Camera: NIDEK AFC-230 — 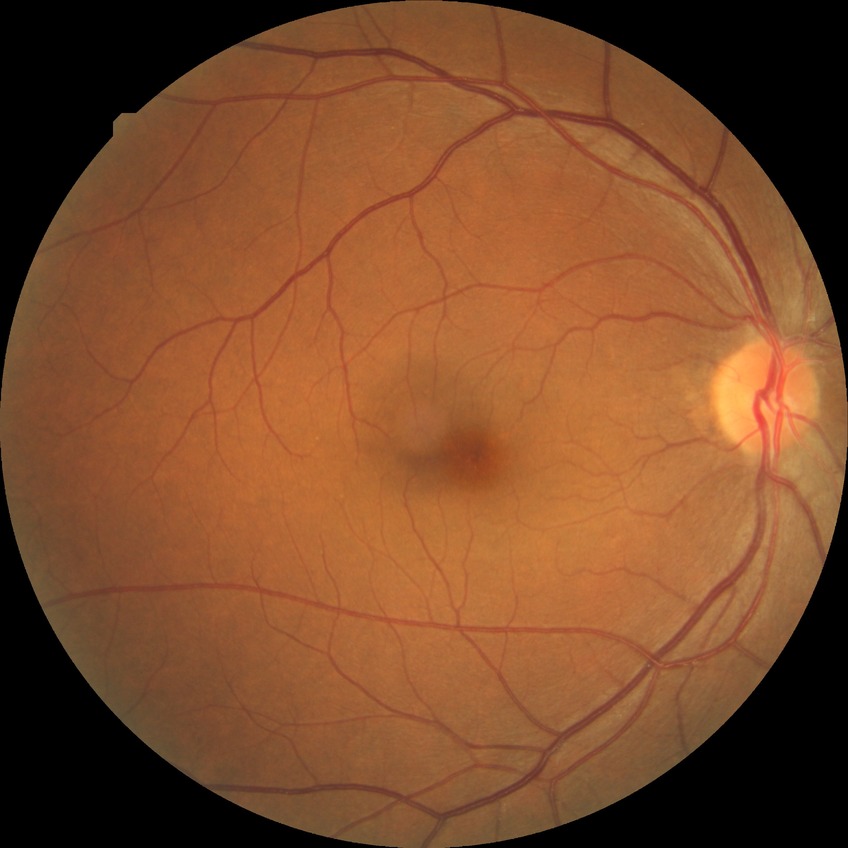 No apparent diabetic retinopathy. DR is NDR.